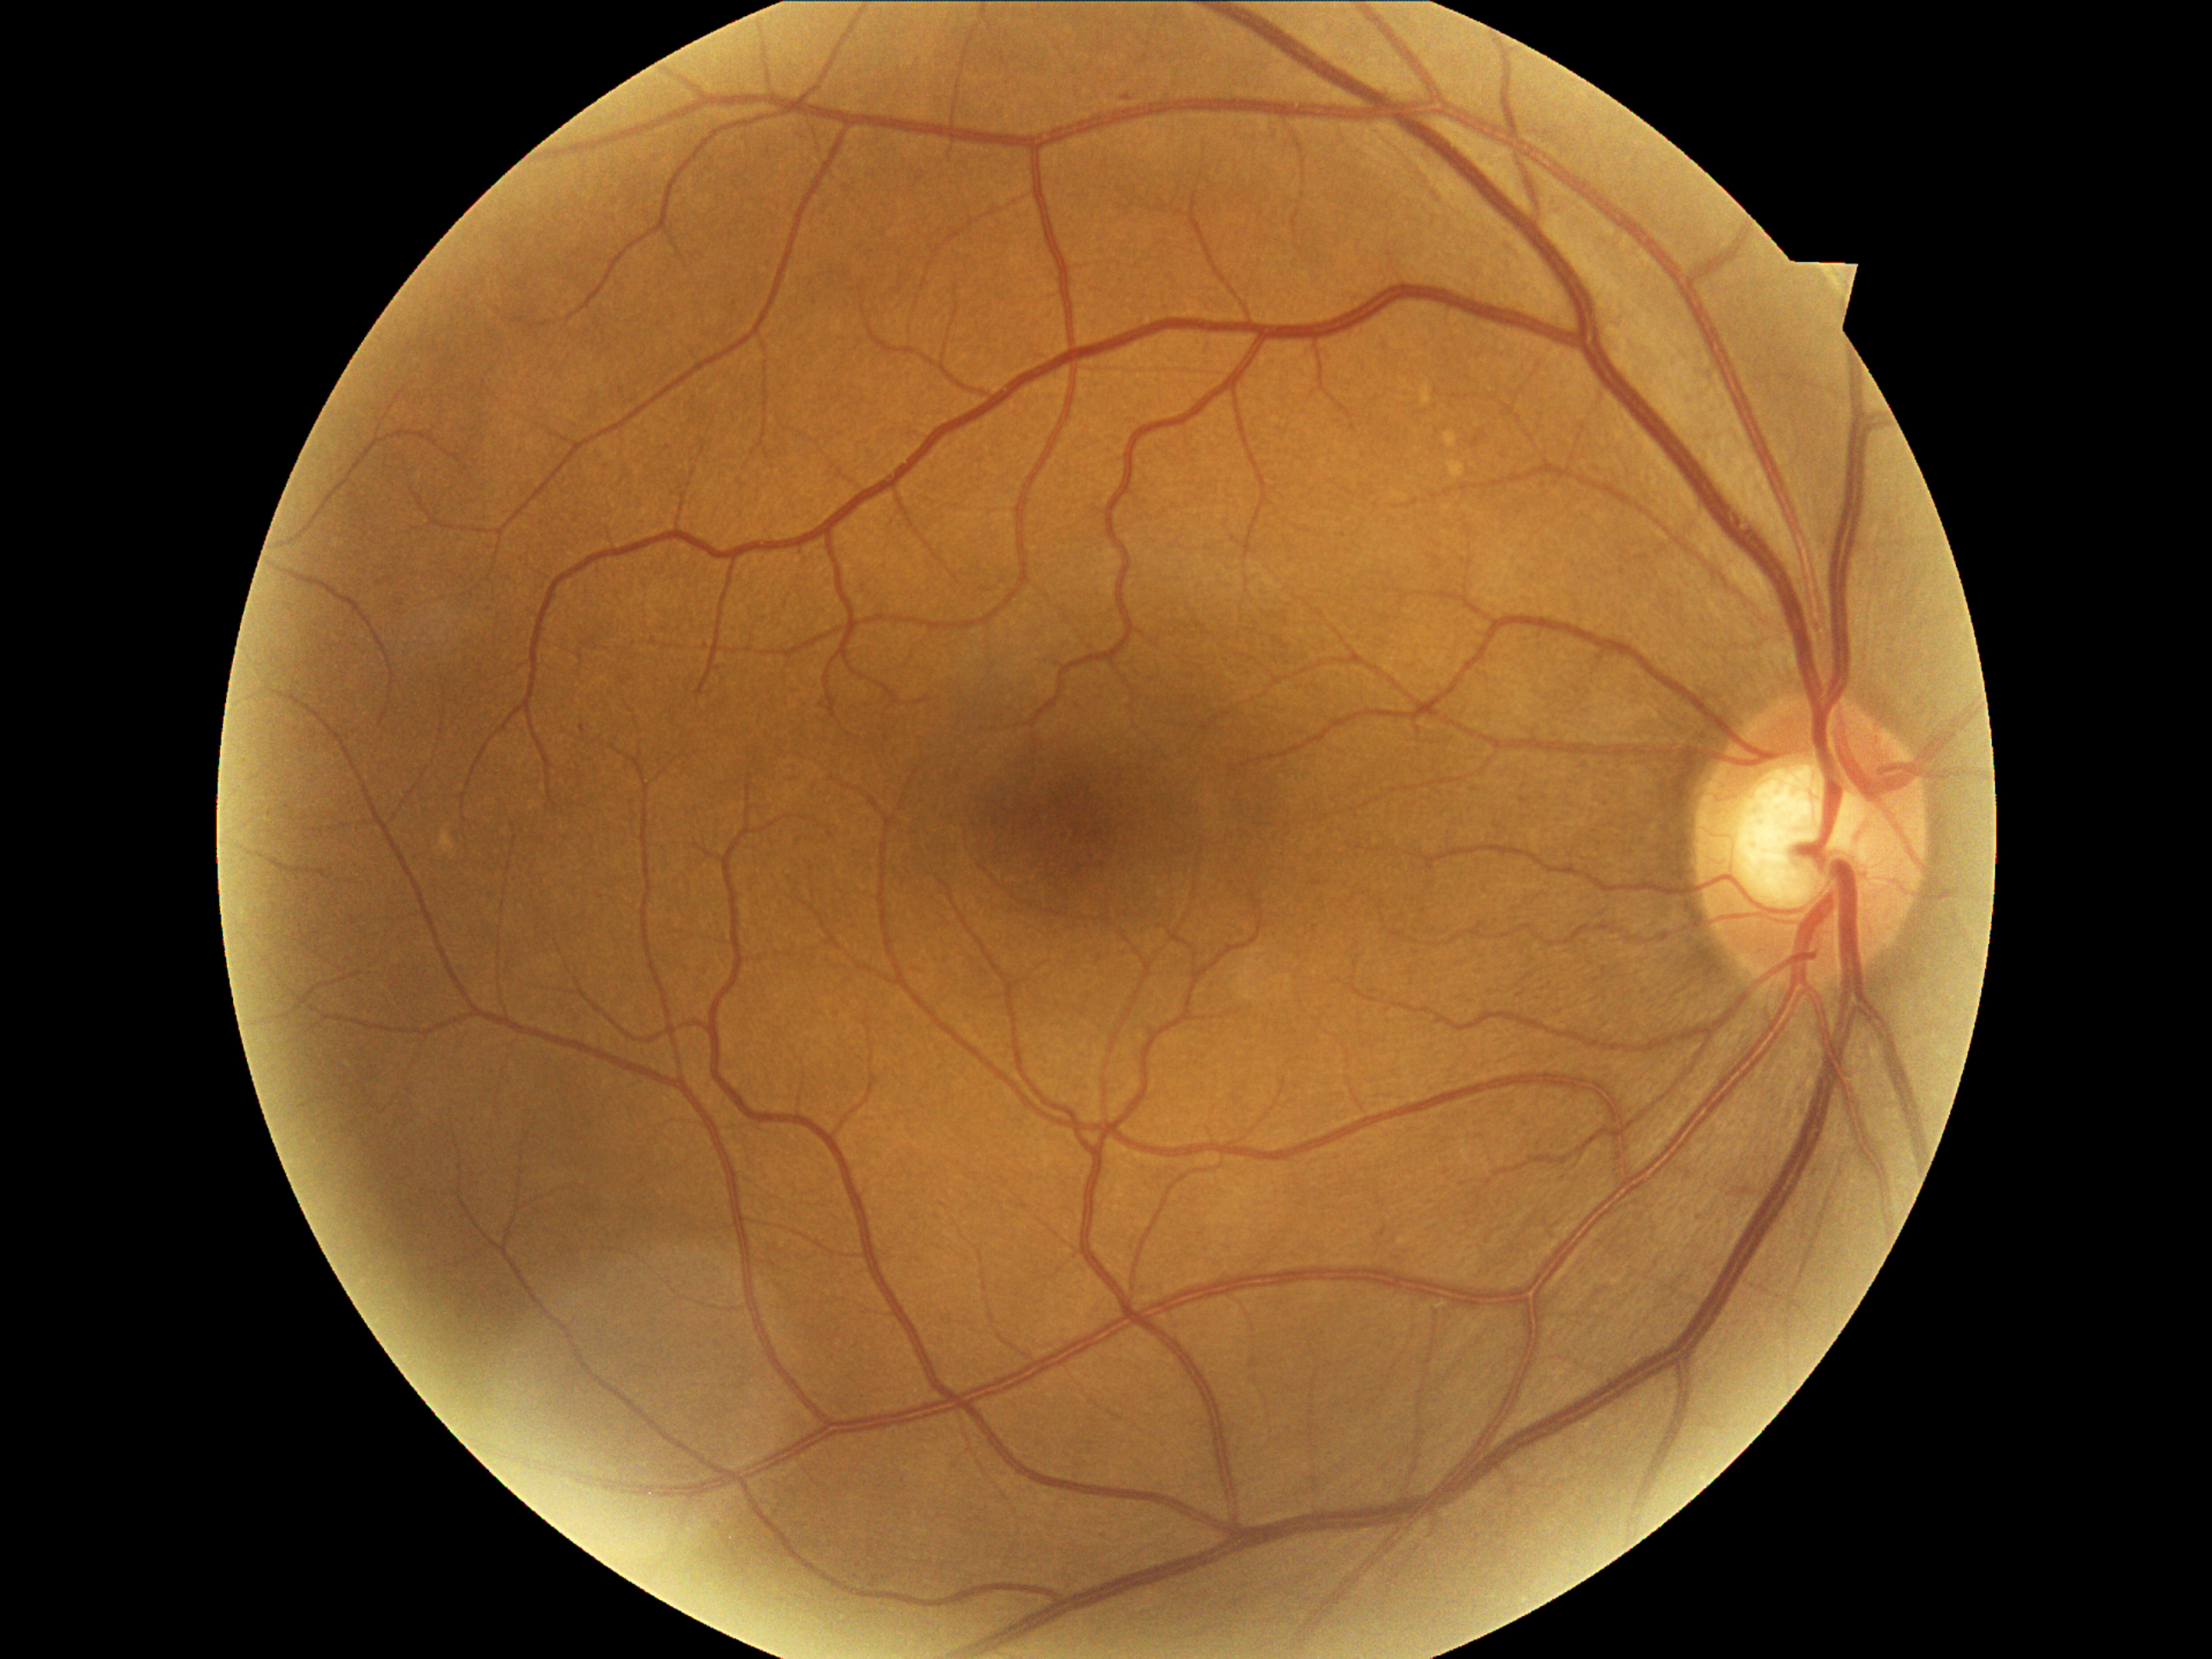 Annotations:
- retinopathy — 1/4 — presence of microaneurysms only
- DR class — non-proliferative diabetic retinopathy